Fundus photo. 45-degree field of view
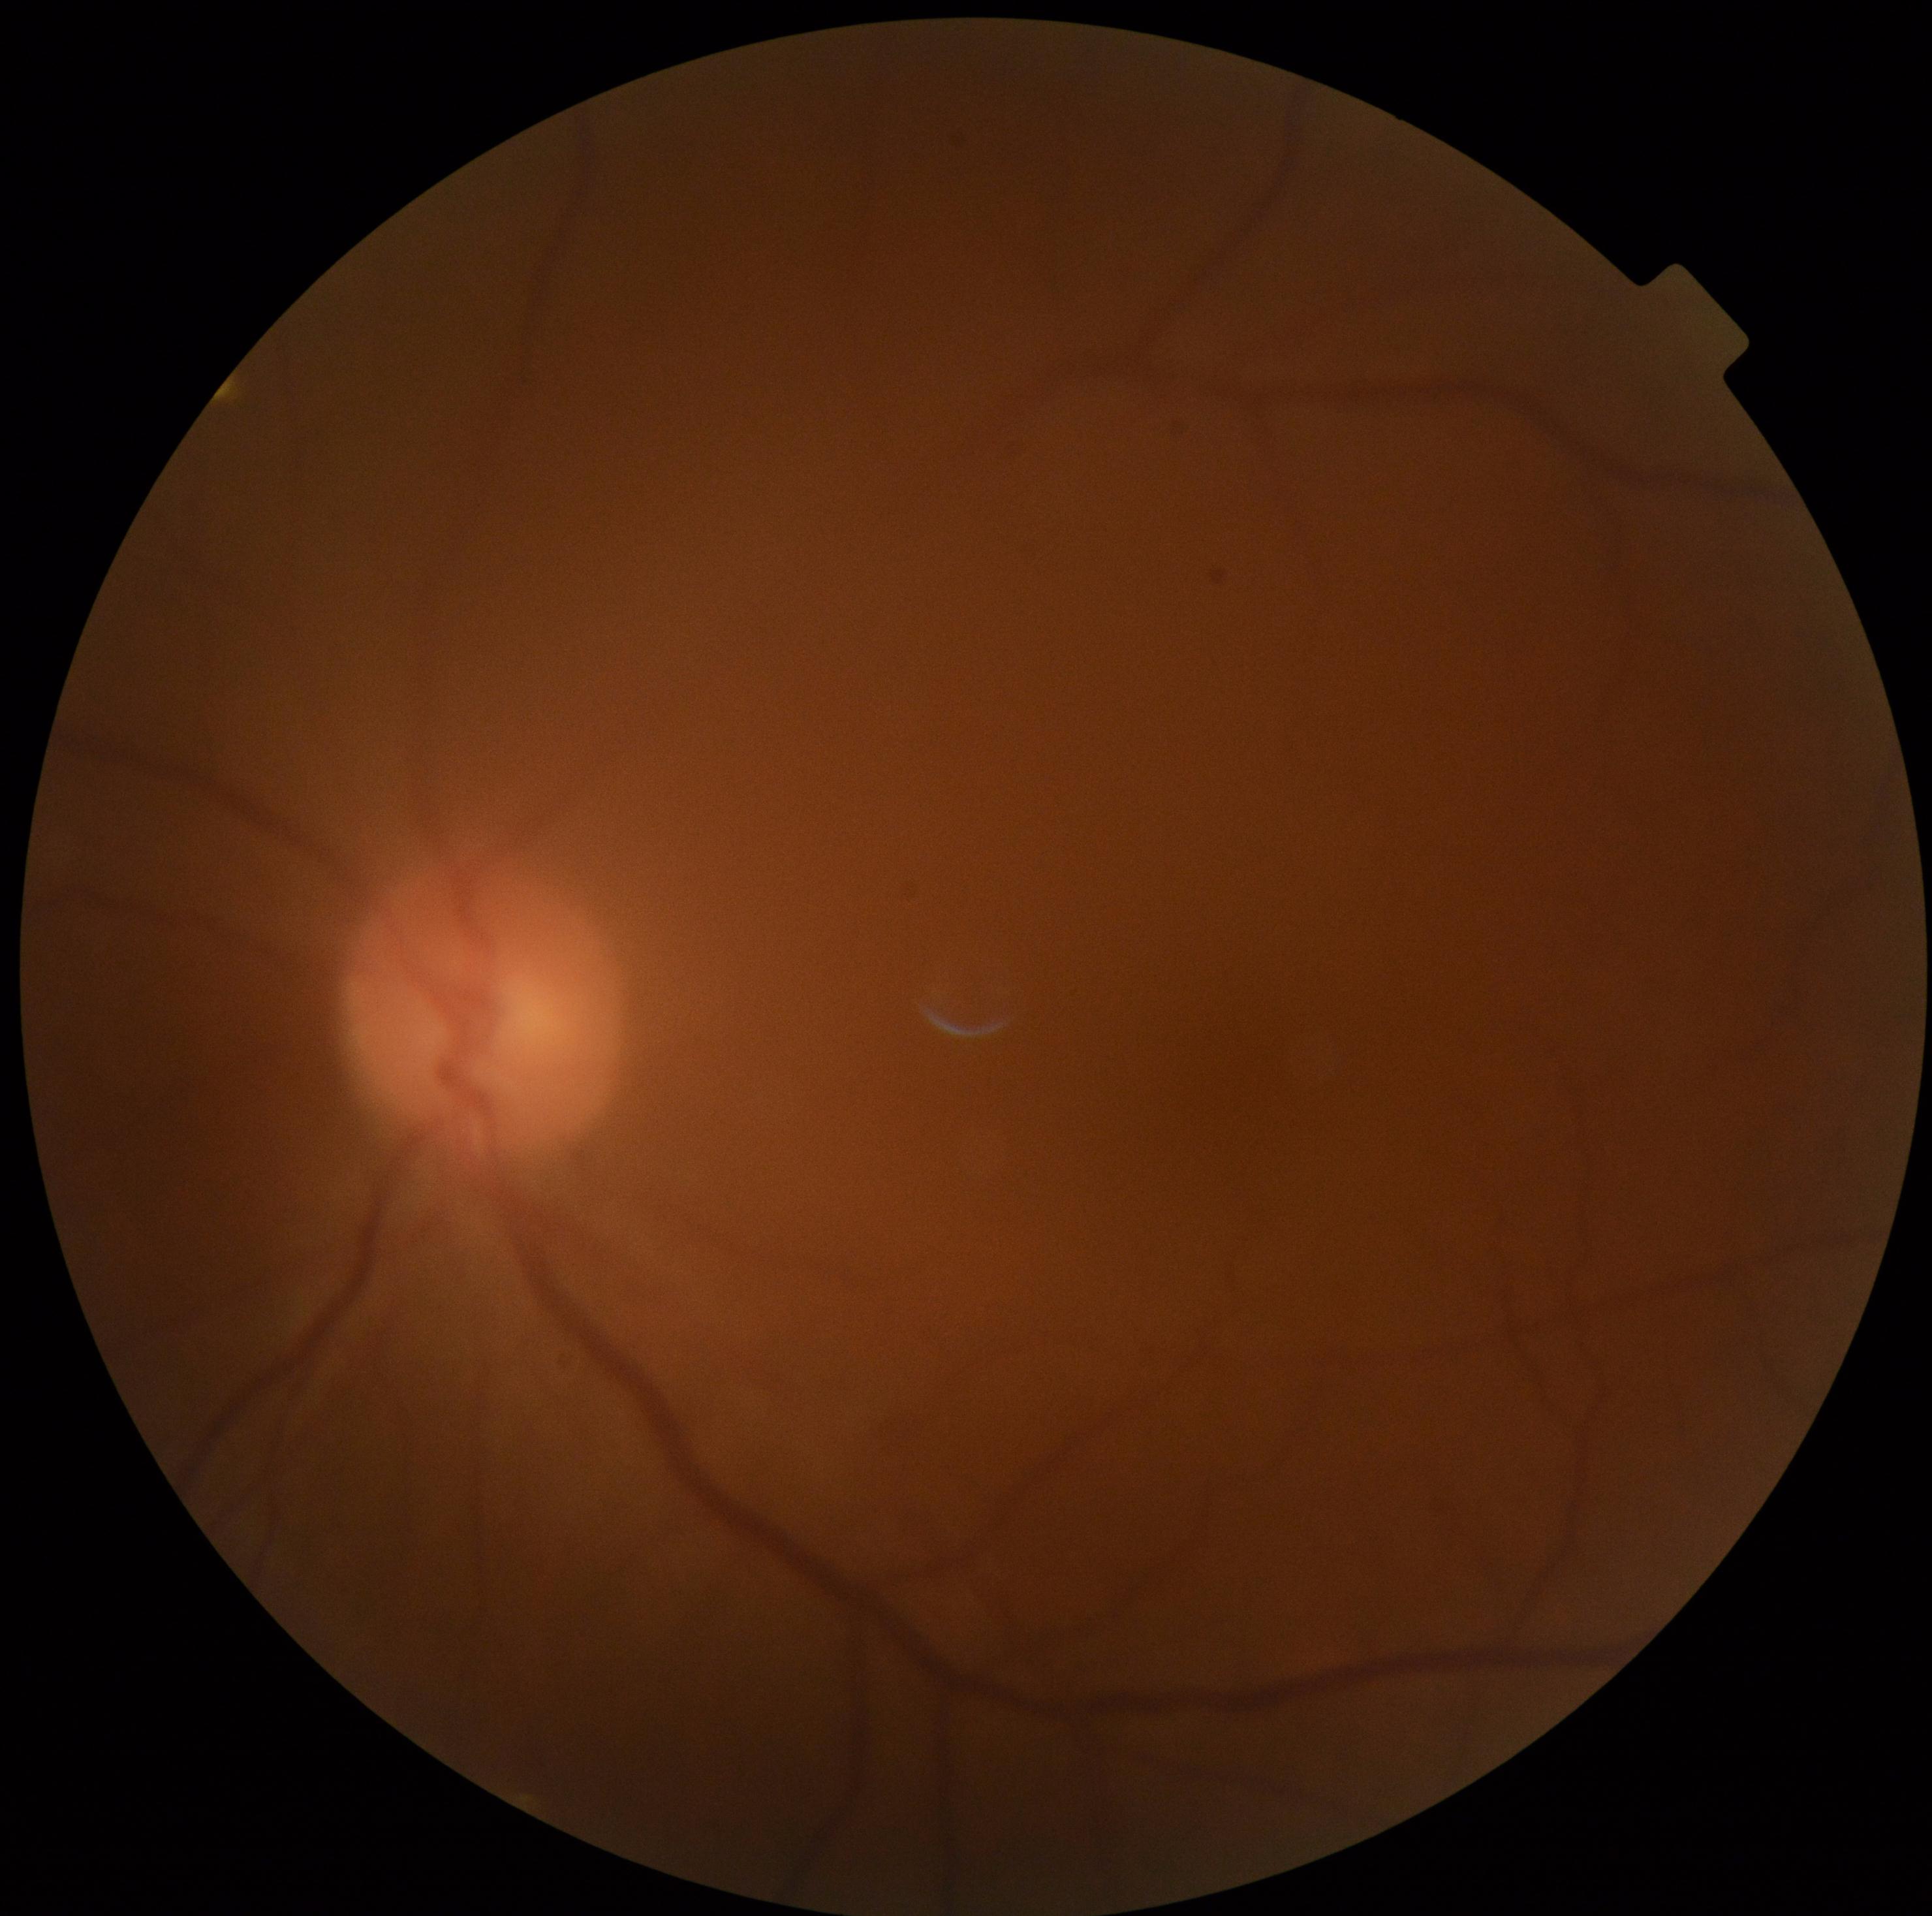 Diabetic retinopathy (DR) is grade 0 (no apparent retinopathy).